45 degree fundus photograph:
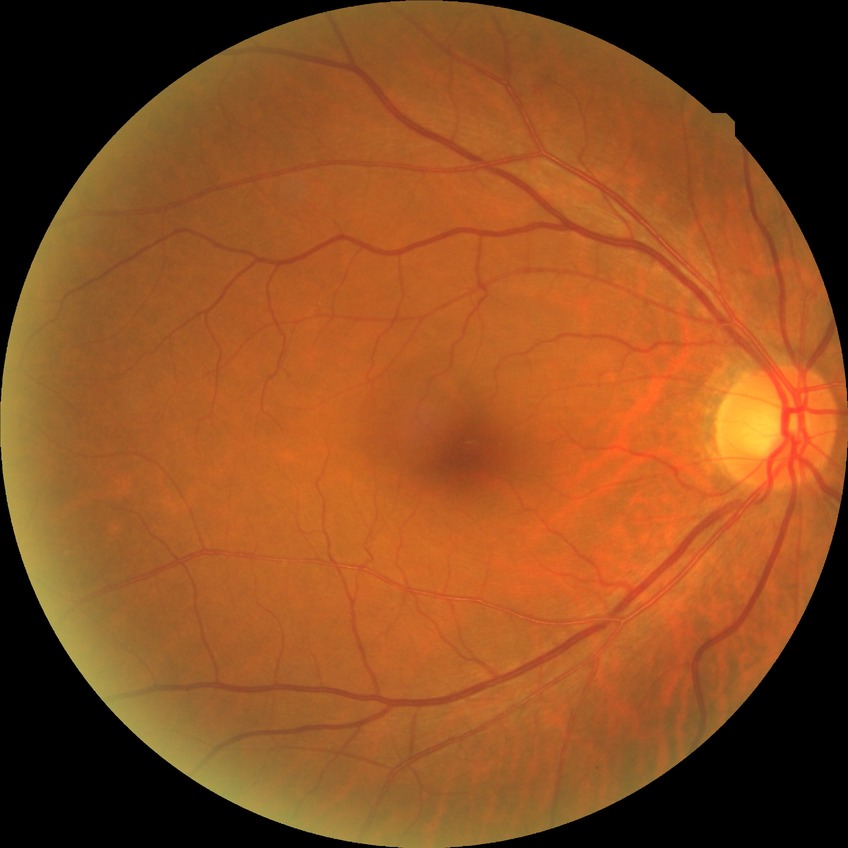

No apparent diabetic retinopathy. DR grade: NDR.